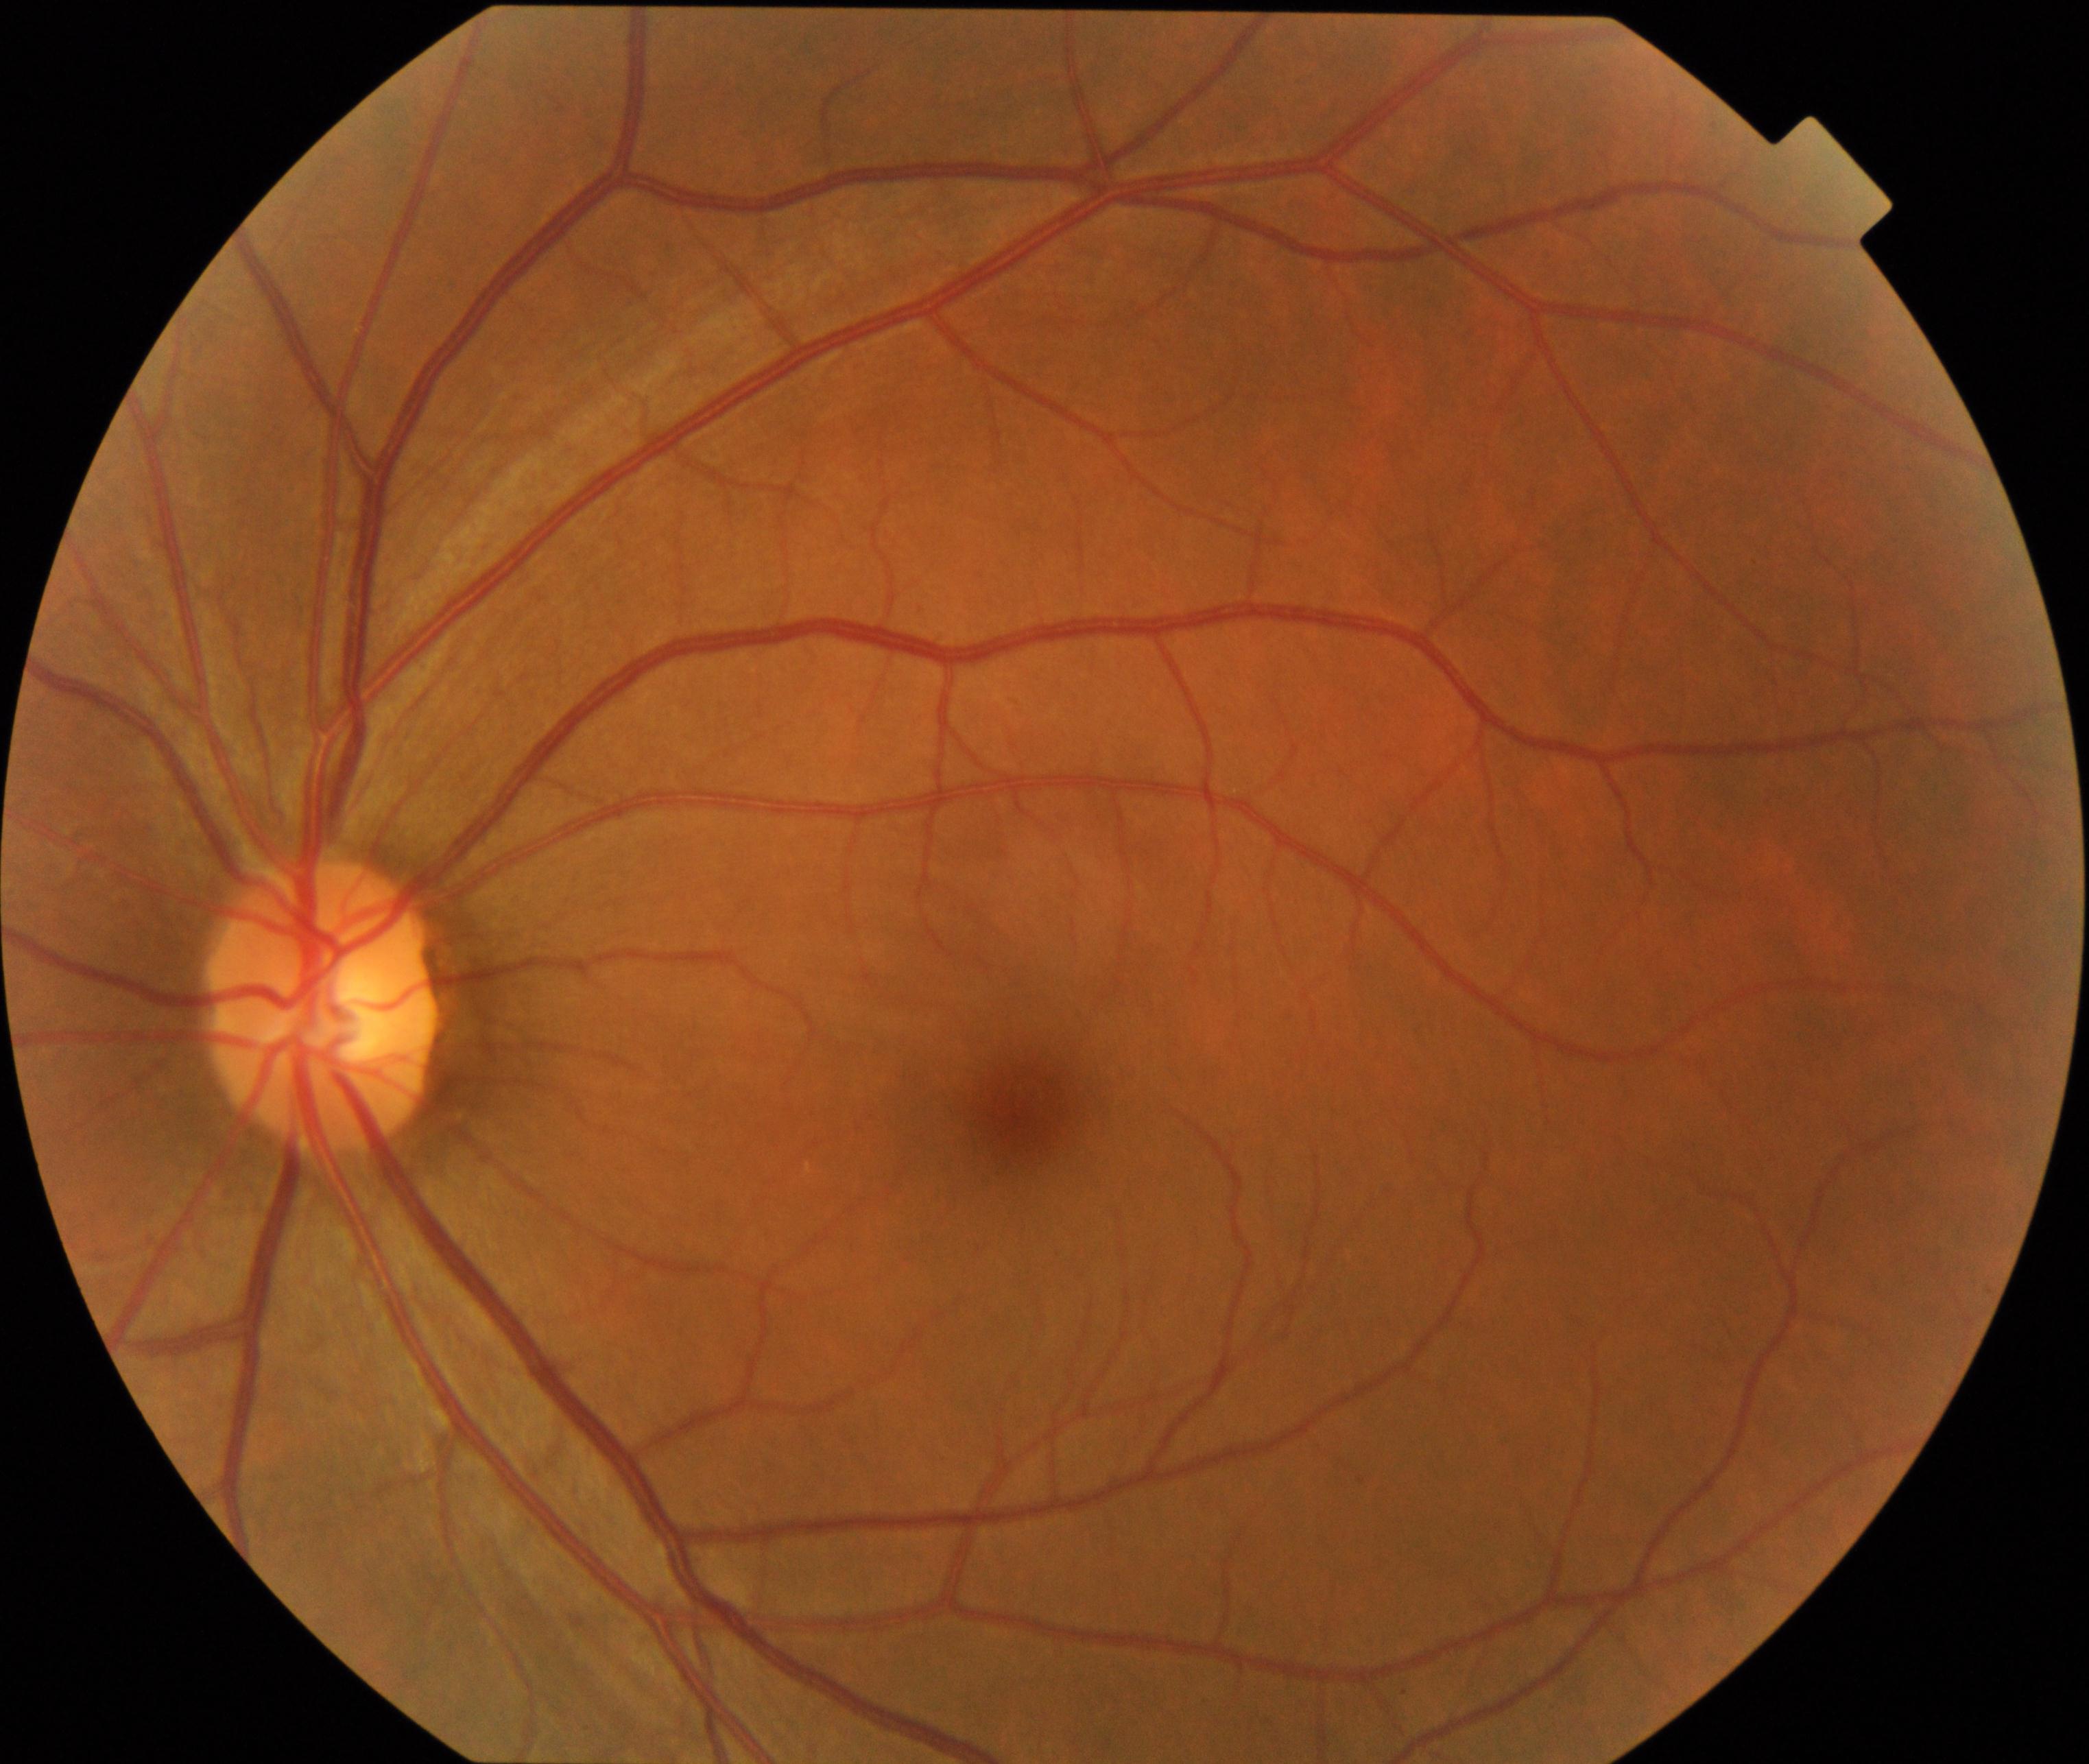 Diagnosis: normal.